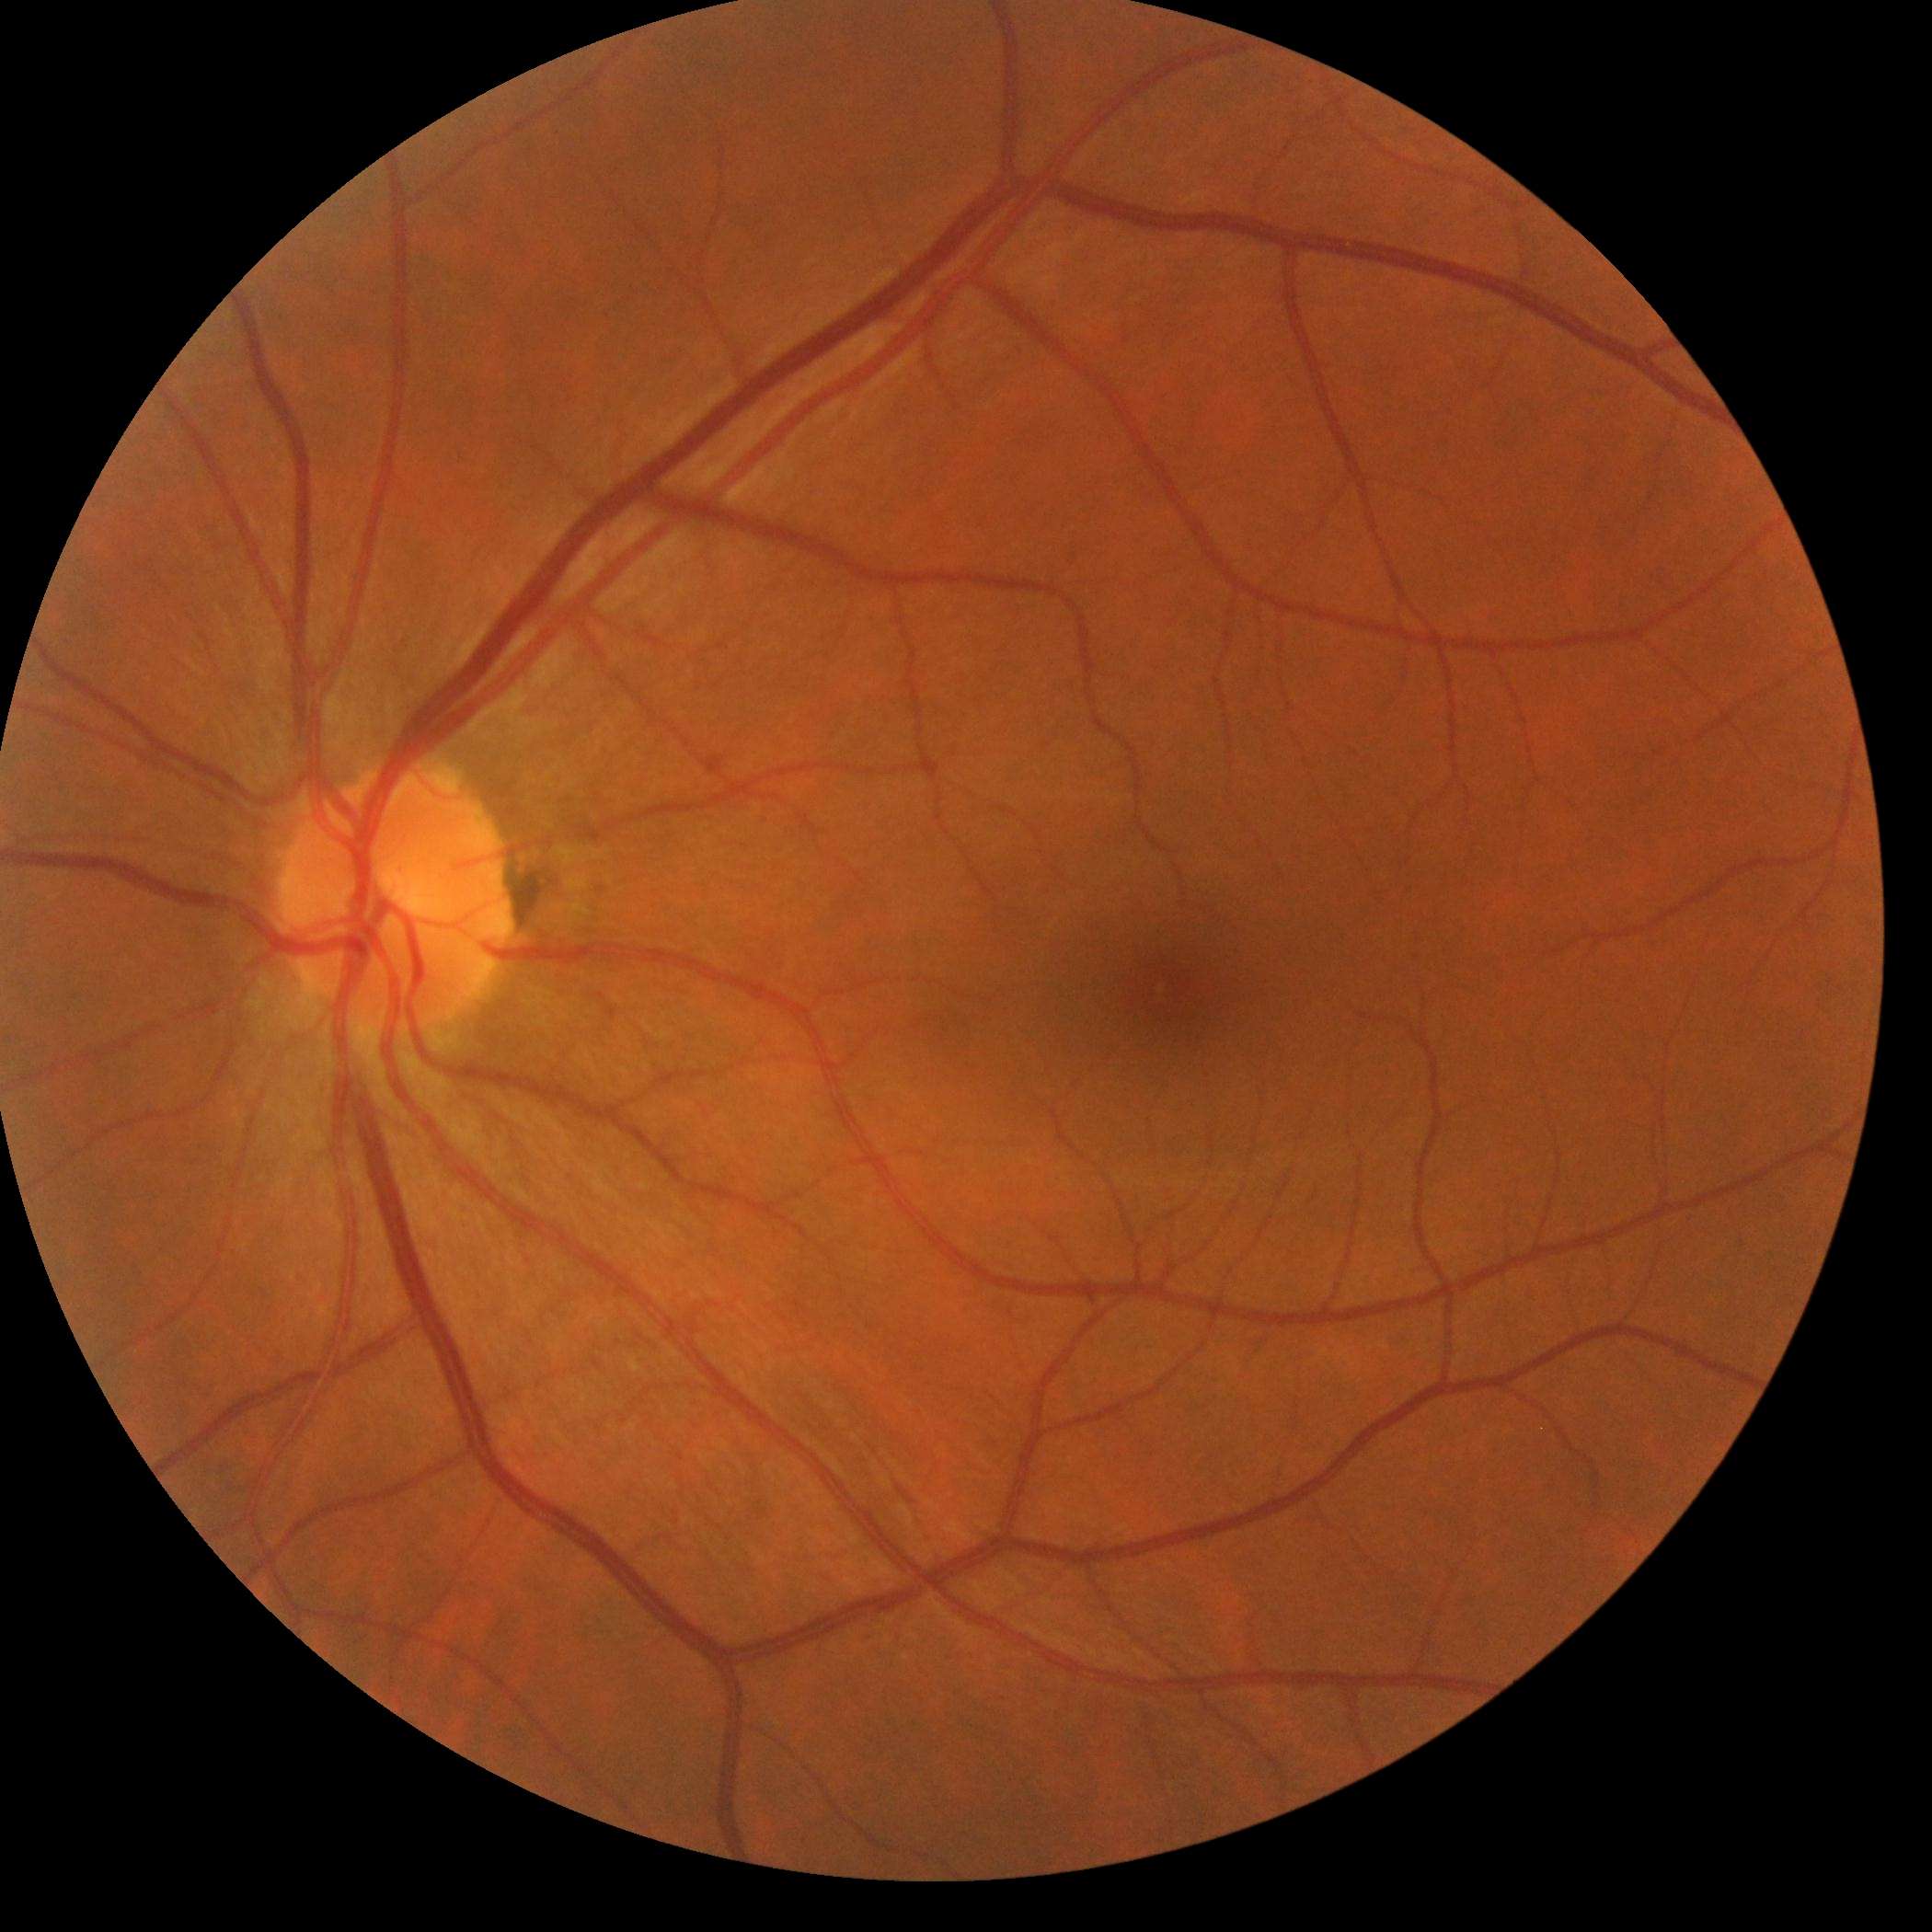 DR grade: no apparent retinopathy (0).